45° field of view, 2184 x 1690 pixels.
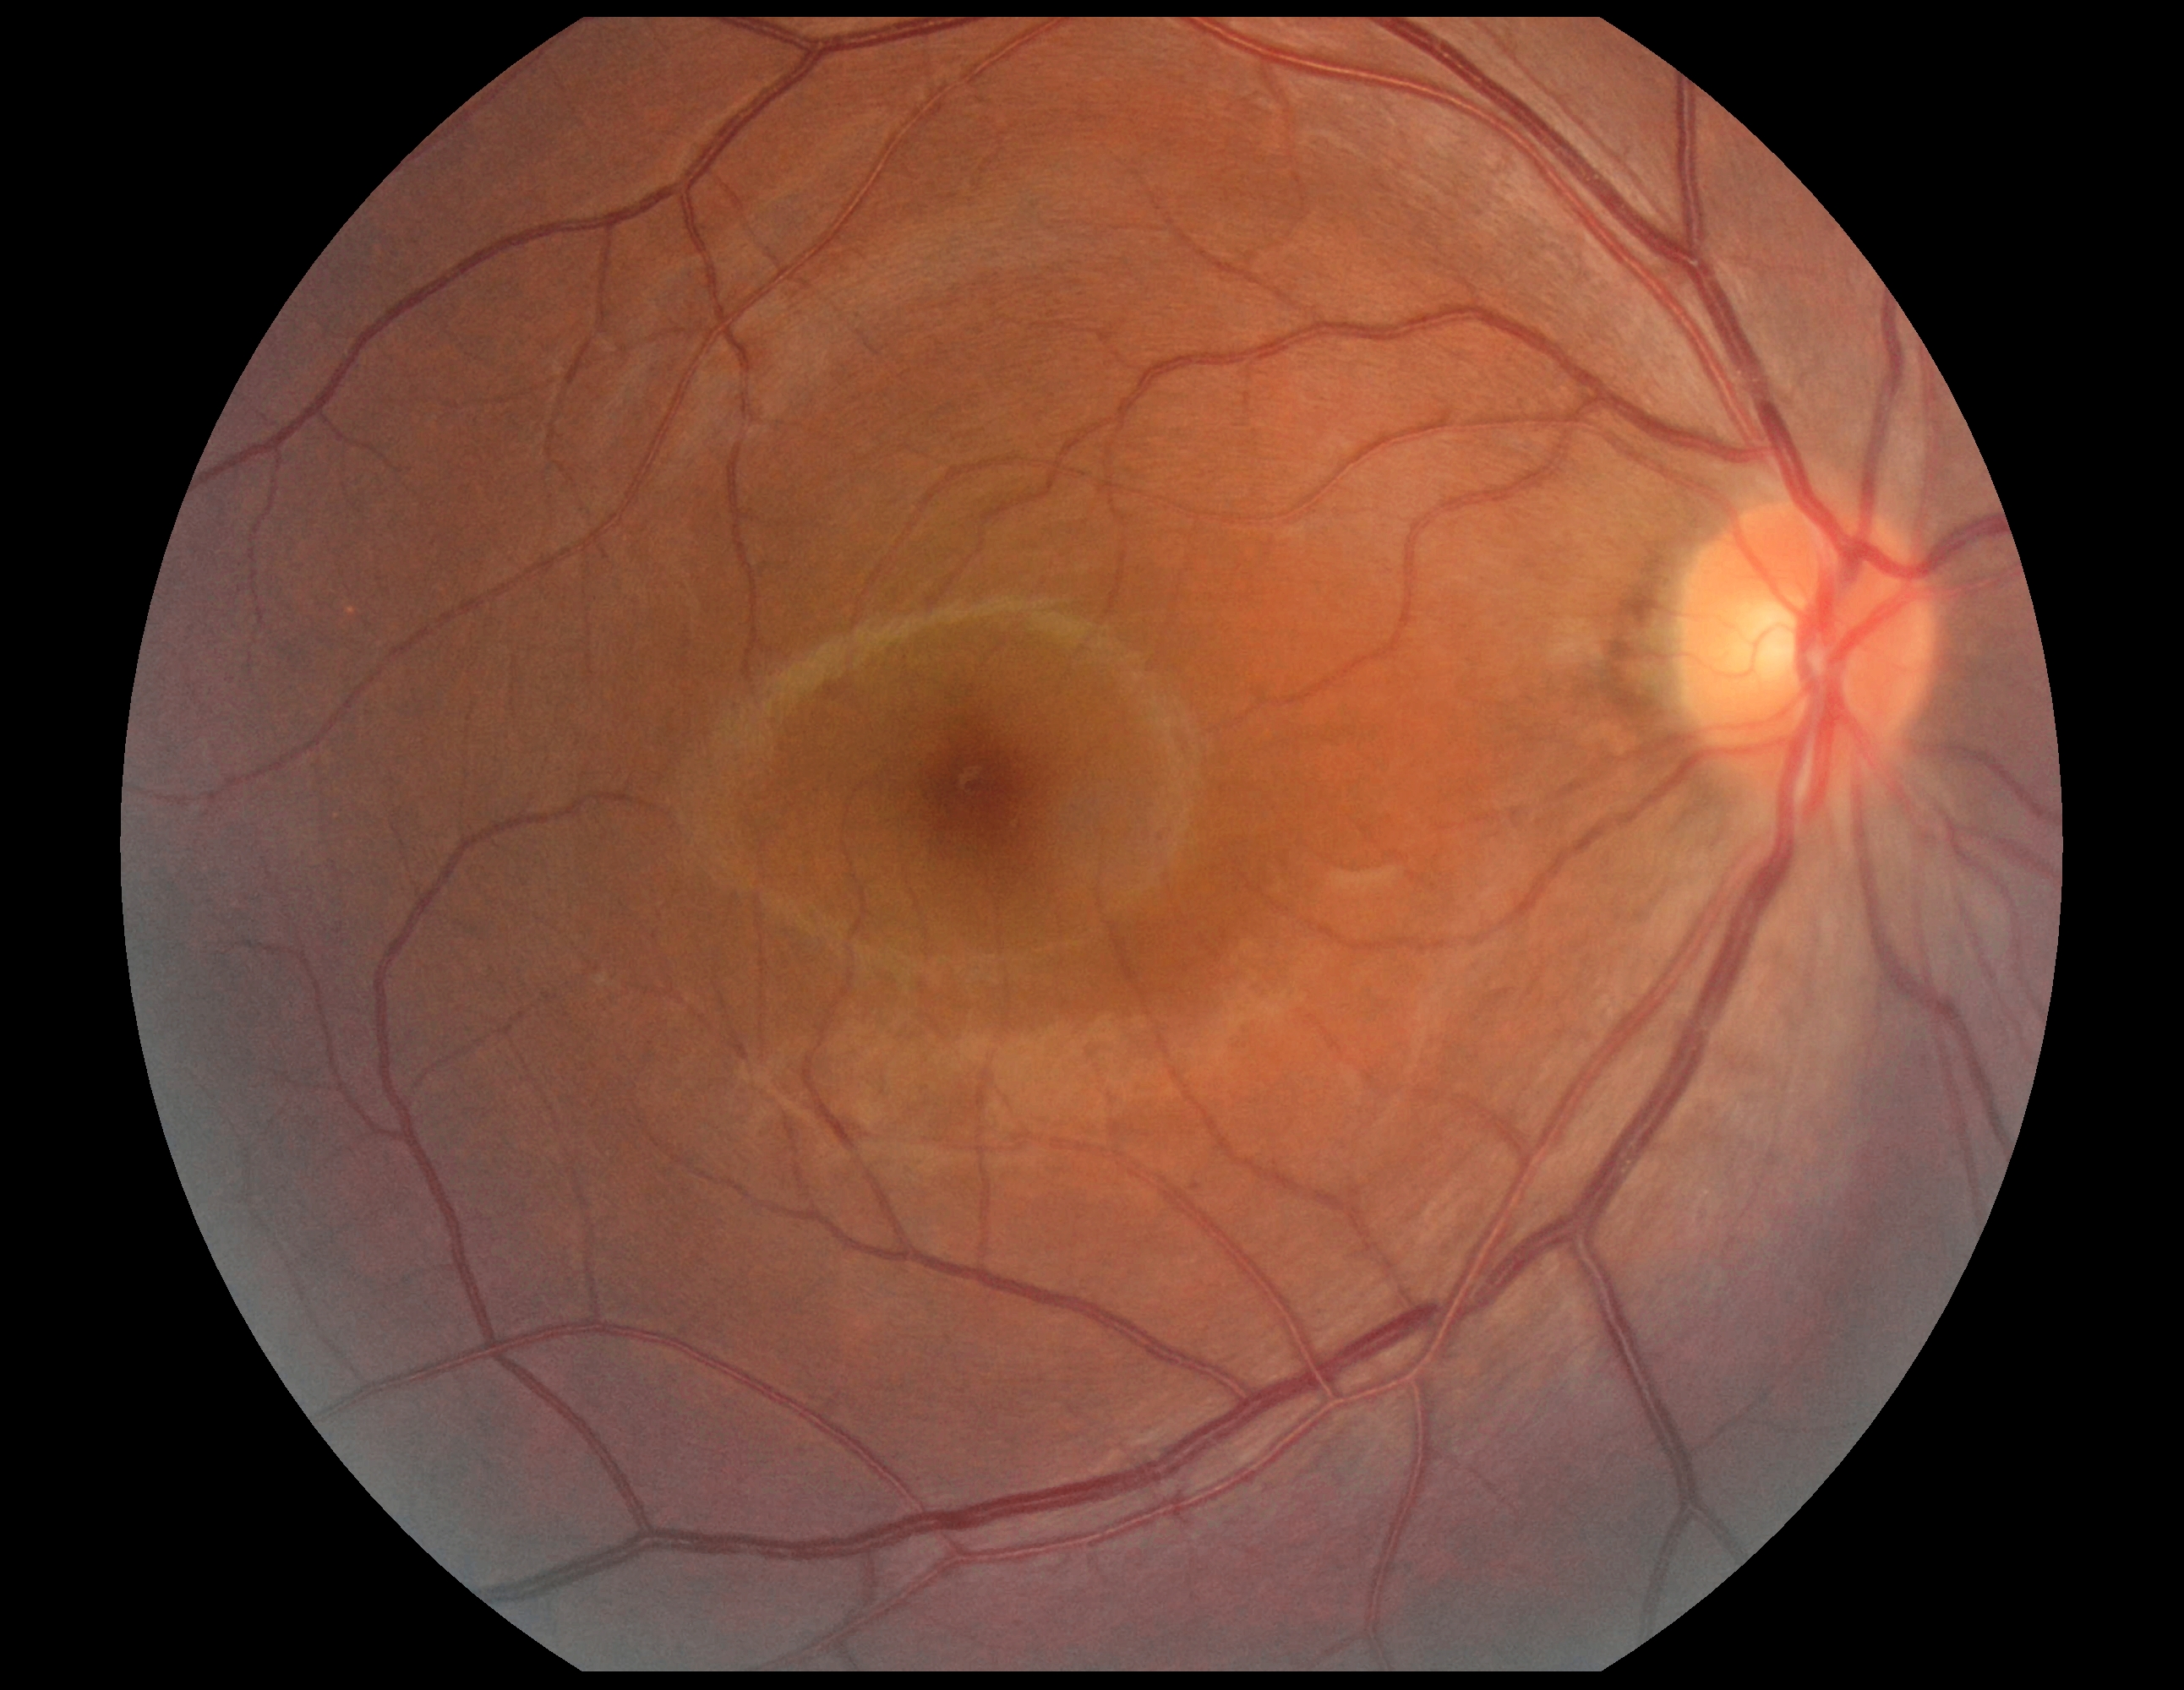

Retinopathy grade: 0.